848x848px, camera: NIDEK AFC-230, no pharmacologic dilation, 45° field of view: 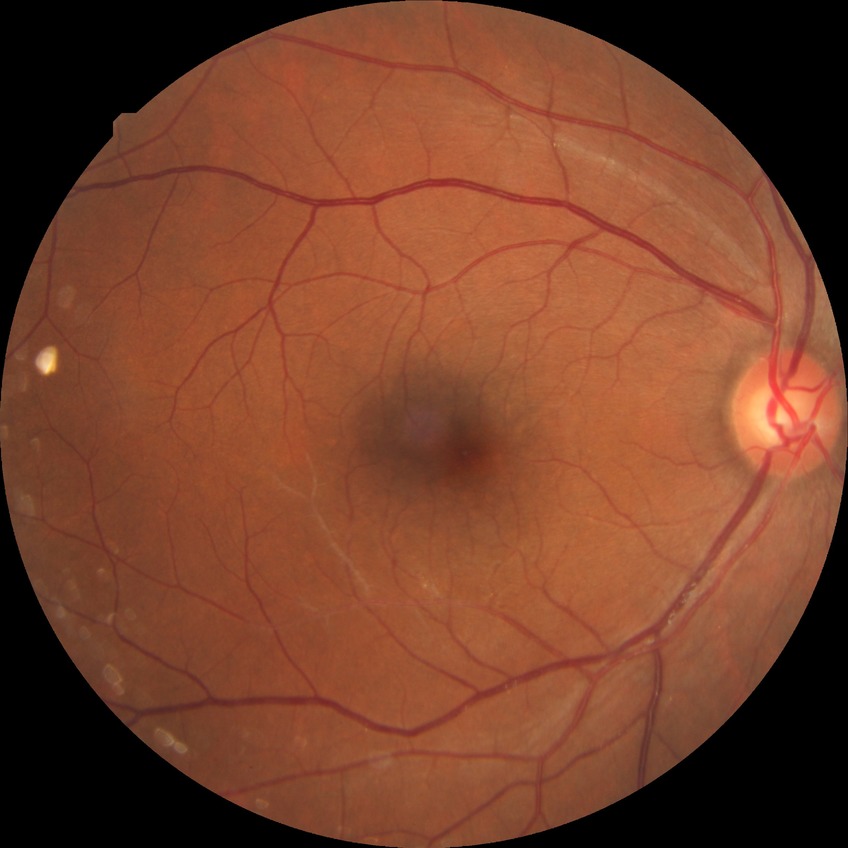

Assessment:
– diabetic retinopathy severity: no diabetic retinopathy